NIDEK AFC-230 fundus camera · 848x848px
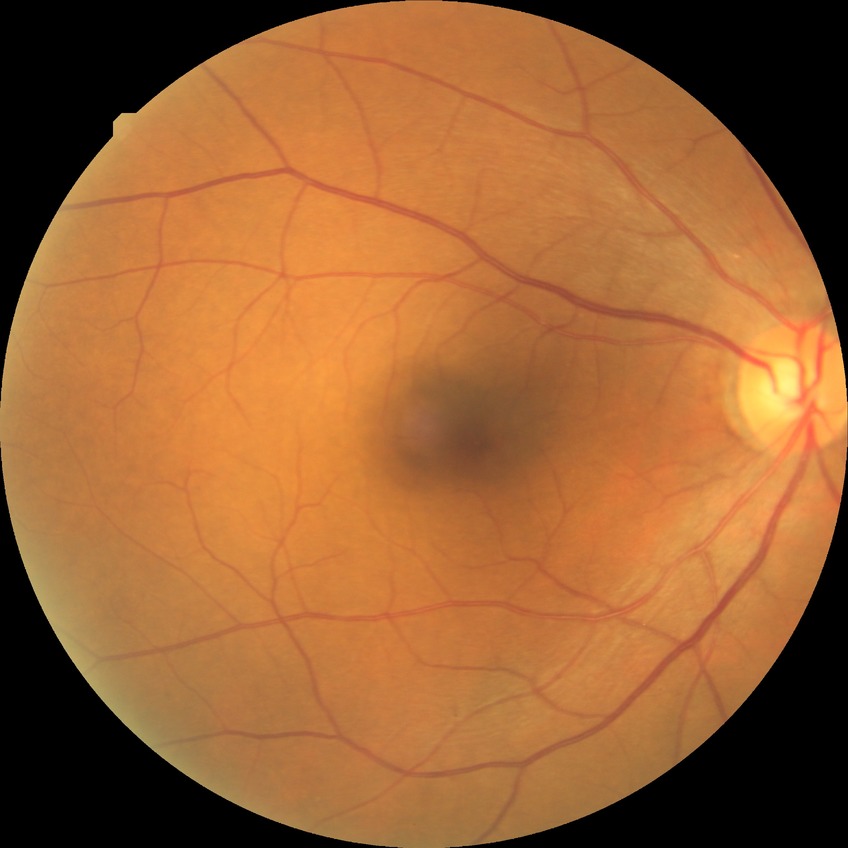 Davis grading: no diabetic retinopathy.